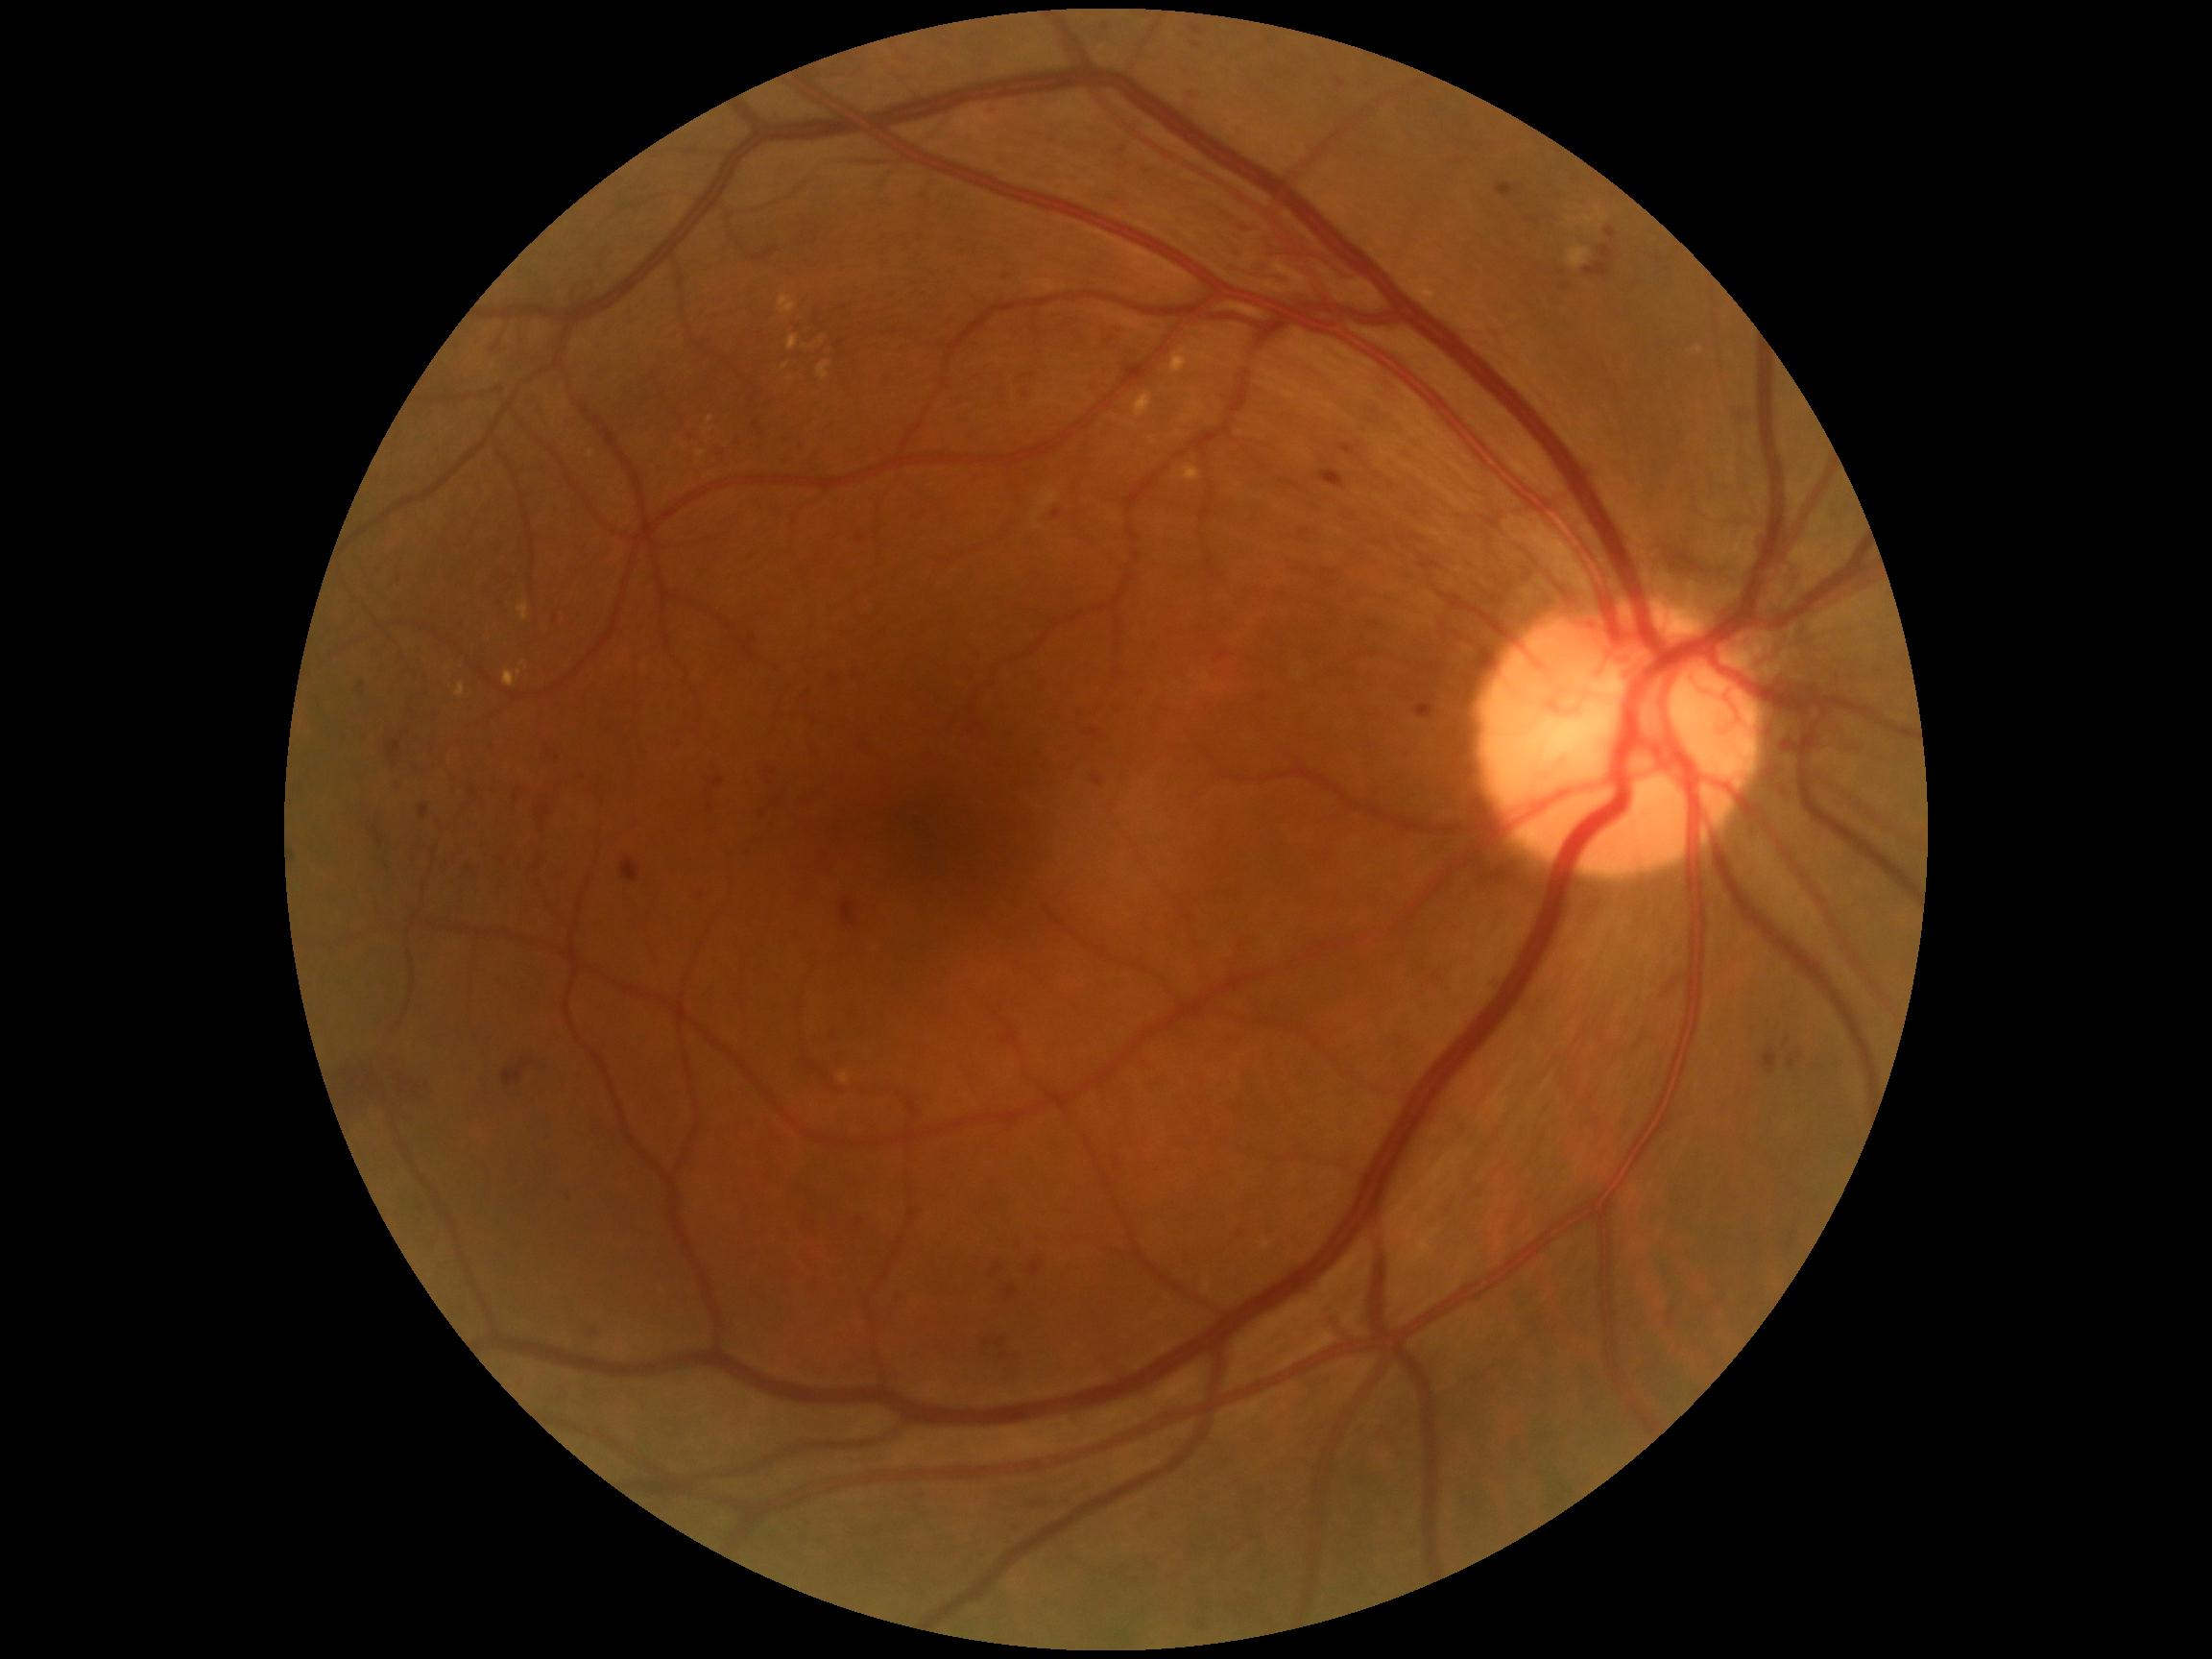 Retinopathy grade: proliferative diabetic retinopathy (4) — neovascularization and/or vitreous/pre-retinal hemorrhage; proliferative diabetic retinopathy
Representative lesions:
hard exudates (partial): region(839, 1073, 851, 1085); region(1170, 348, 1188, 374); region(696, 452, 706, 458); region(1584, 217, 1594, 226); region(1598, 207, 1608, 223); region(818, 362, 831, 383); region(518, 603, 529, 622); region(779, 296, 798, 314)
Hard exudates (small, approximate centers) near (711, 420); (786, 367); (791, 379); (523, 664)
microaneurysms (partial): region(857, 536, 865, 545); region(796, 439, 801, 448); region(1369, 622, 1379, 629); region(1053, 512, 1063, 521); region(577, 768, 589, 781); region(836, 341, 844, 349); region(1133, 684, 1146, 694); region(1496, 183, 1515, 198); region(560, 1189, 571, 1197); region(354, 679, 364, 691); region(1085, 730, 1099, 738)
Microaneurysms (small, approximate centers) near (817, 316)
hemorrhages (partial): region(1319, 471, 1345, 489); region(777, 447, 815, 467); region(1599, 247, 1615, 261); region(502, 1061, 528, 1087); region(534, 861, 541, 873); region(390, 780, 400, 789); region(997, 1338, 1004, 1350); region(1789, 1056, 1796, 1069); region(848, 672, 858, 684); region(758, 796, 789, 823); region(464, 858, 478, 880); region(842, 903, 858, 926); region(1785, 1038, 1791, 1046); region(1335, 78, 1347, 89); region(405, 763, 419, 780); region(823, 672, 832, 686); region(572, 770, 587, 781); region(1584, 264, 1610, 278)
Hemorrhages (small, approximate centers) near (1799, 1057)